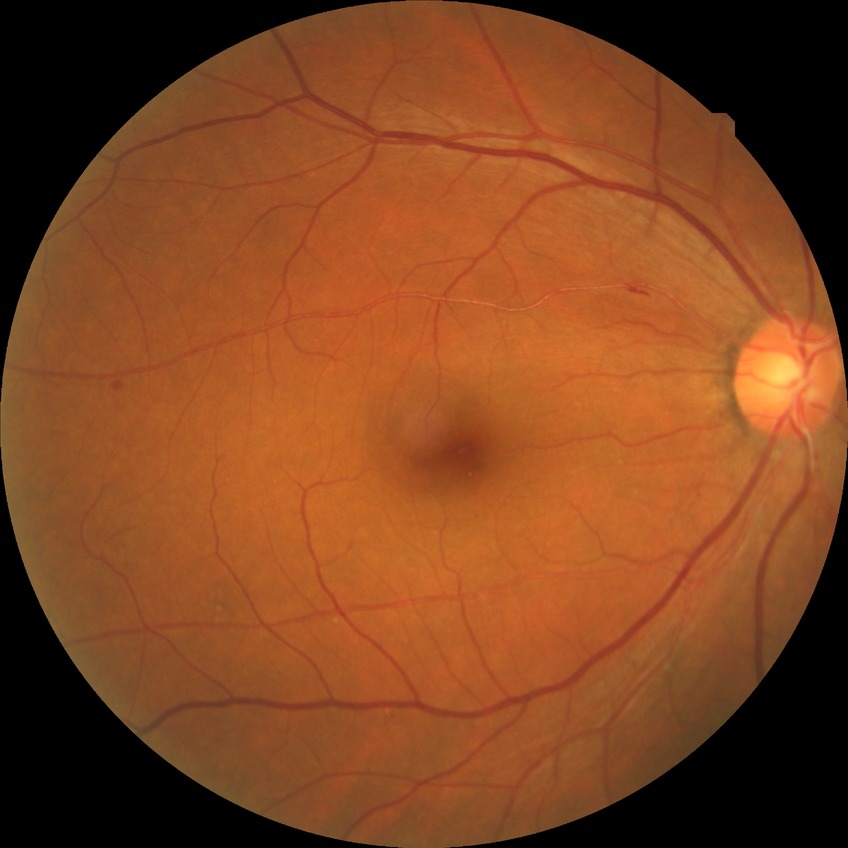 Diabetic retinopathy (DR) is simple diabetic retinopathy (SDR).